Davis DR grading; NIDEK AFC-230: 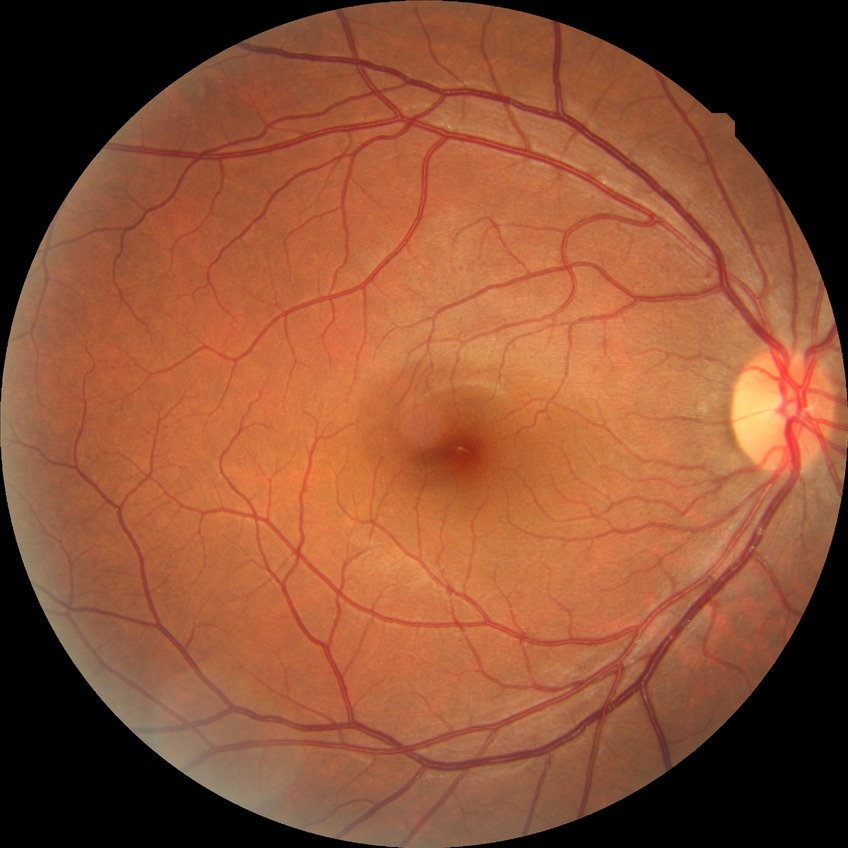
Diabetic retinopathy (DR) is NDR (no diabetic retinopathy).